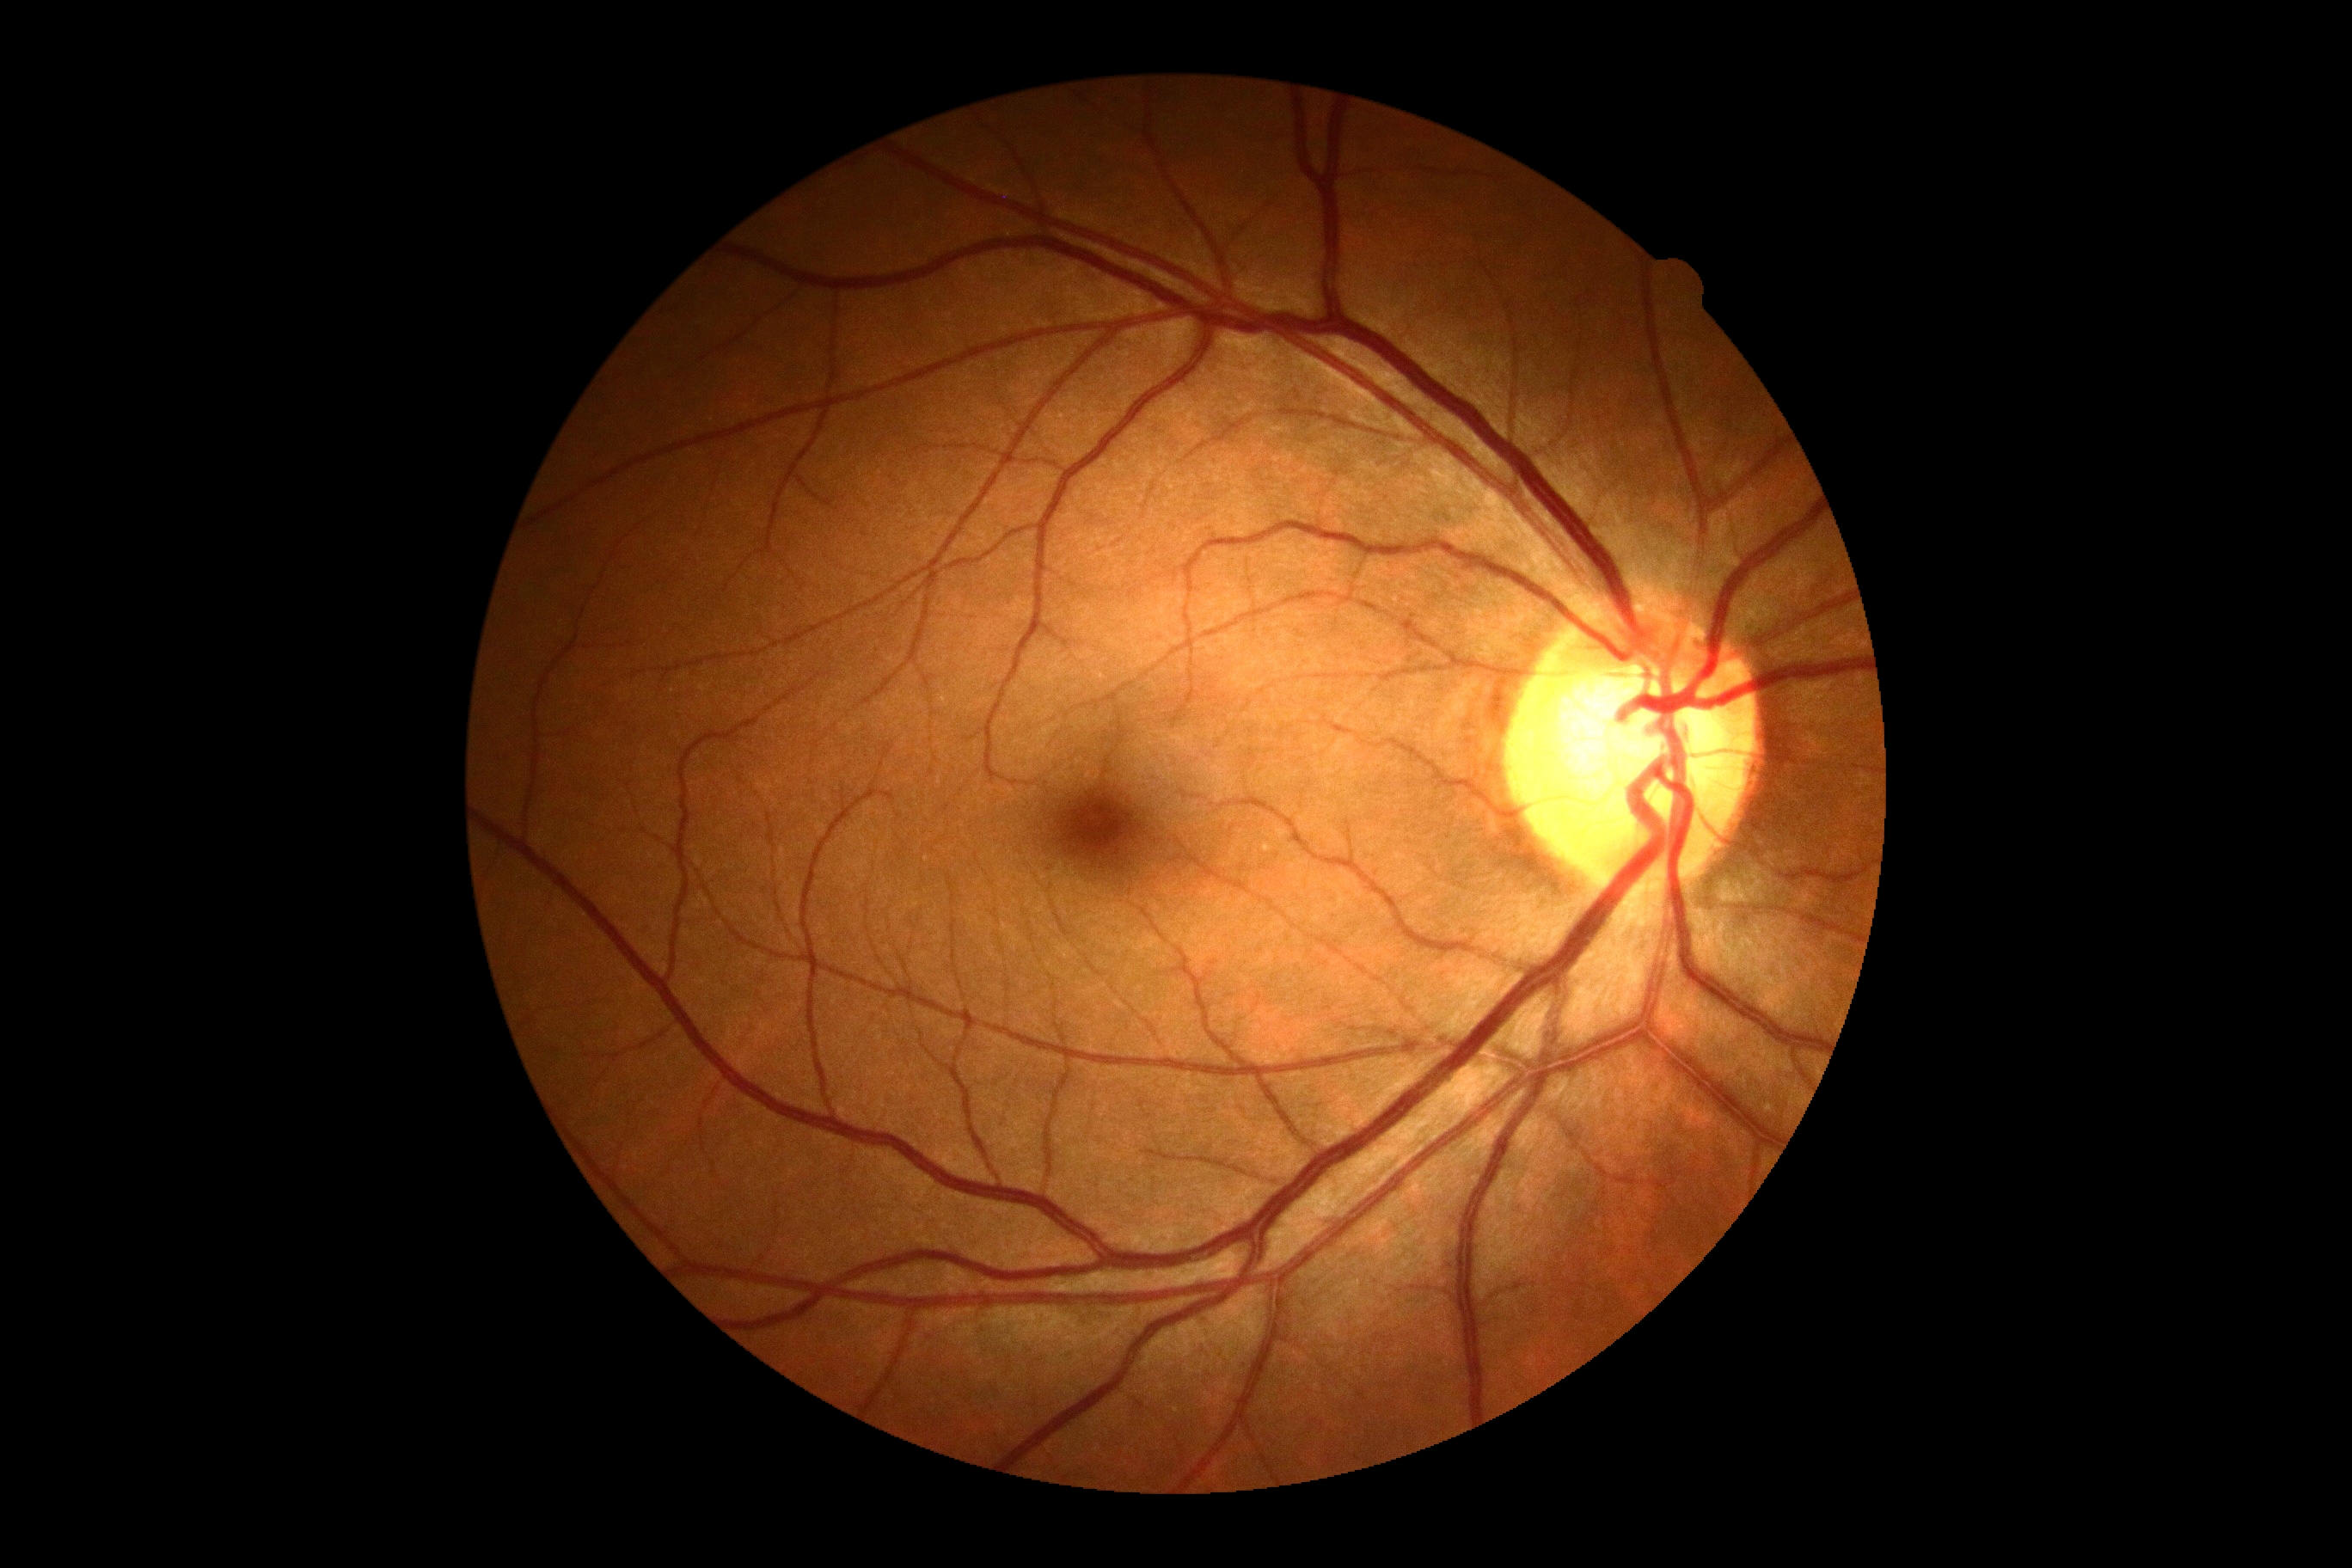

diabetic retinopathy grade: 0/4.